NIDEK AFC-230.
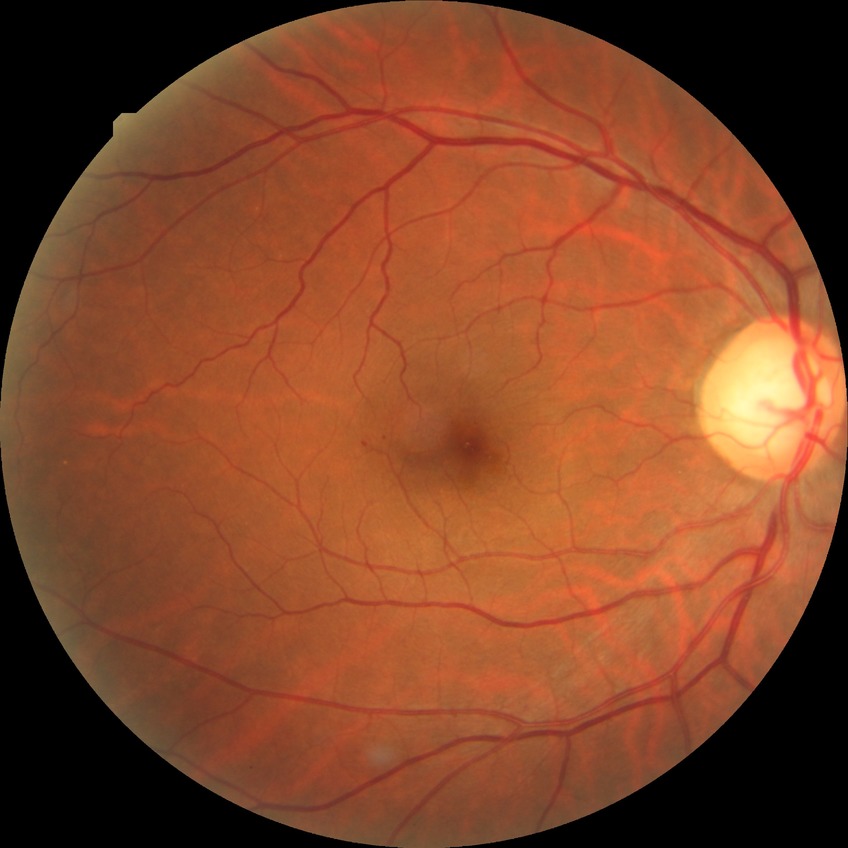
DR is SDR.